NIDEK AFC-230 fundus camera
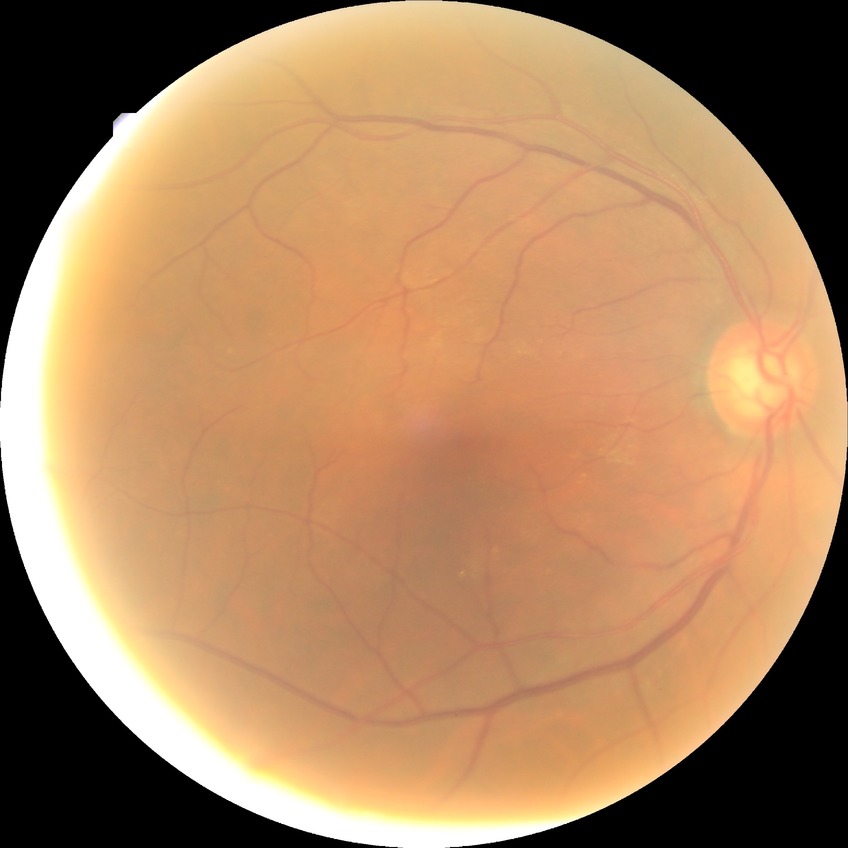 diabetic retinopathy (DR)@no diabetic retinopathy (NDR).